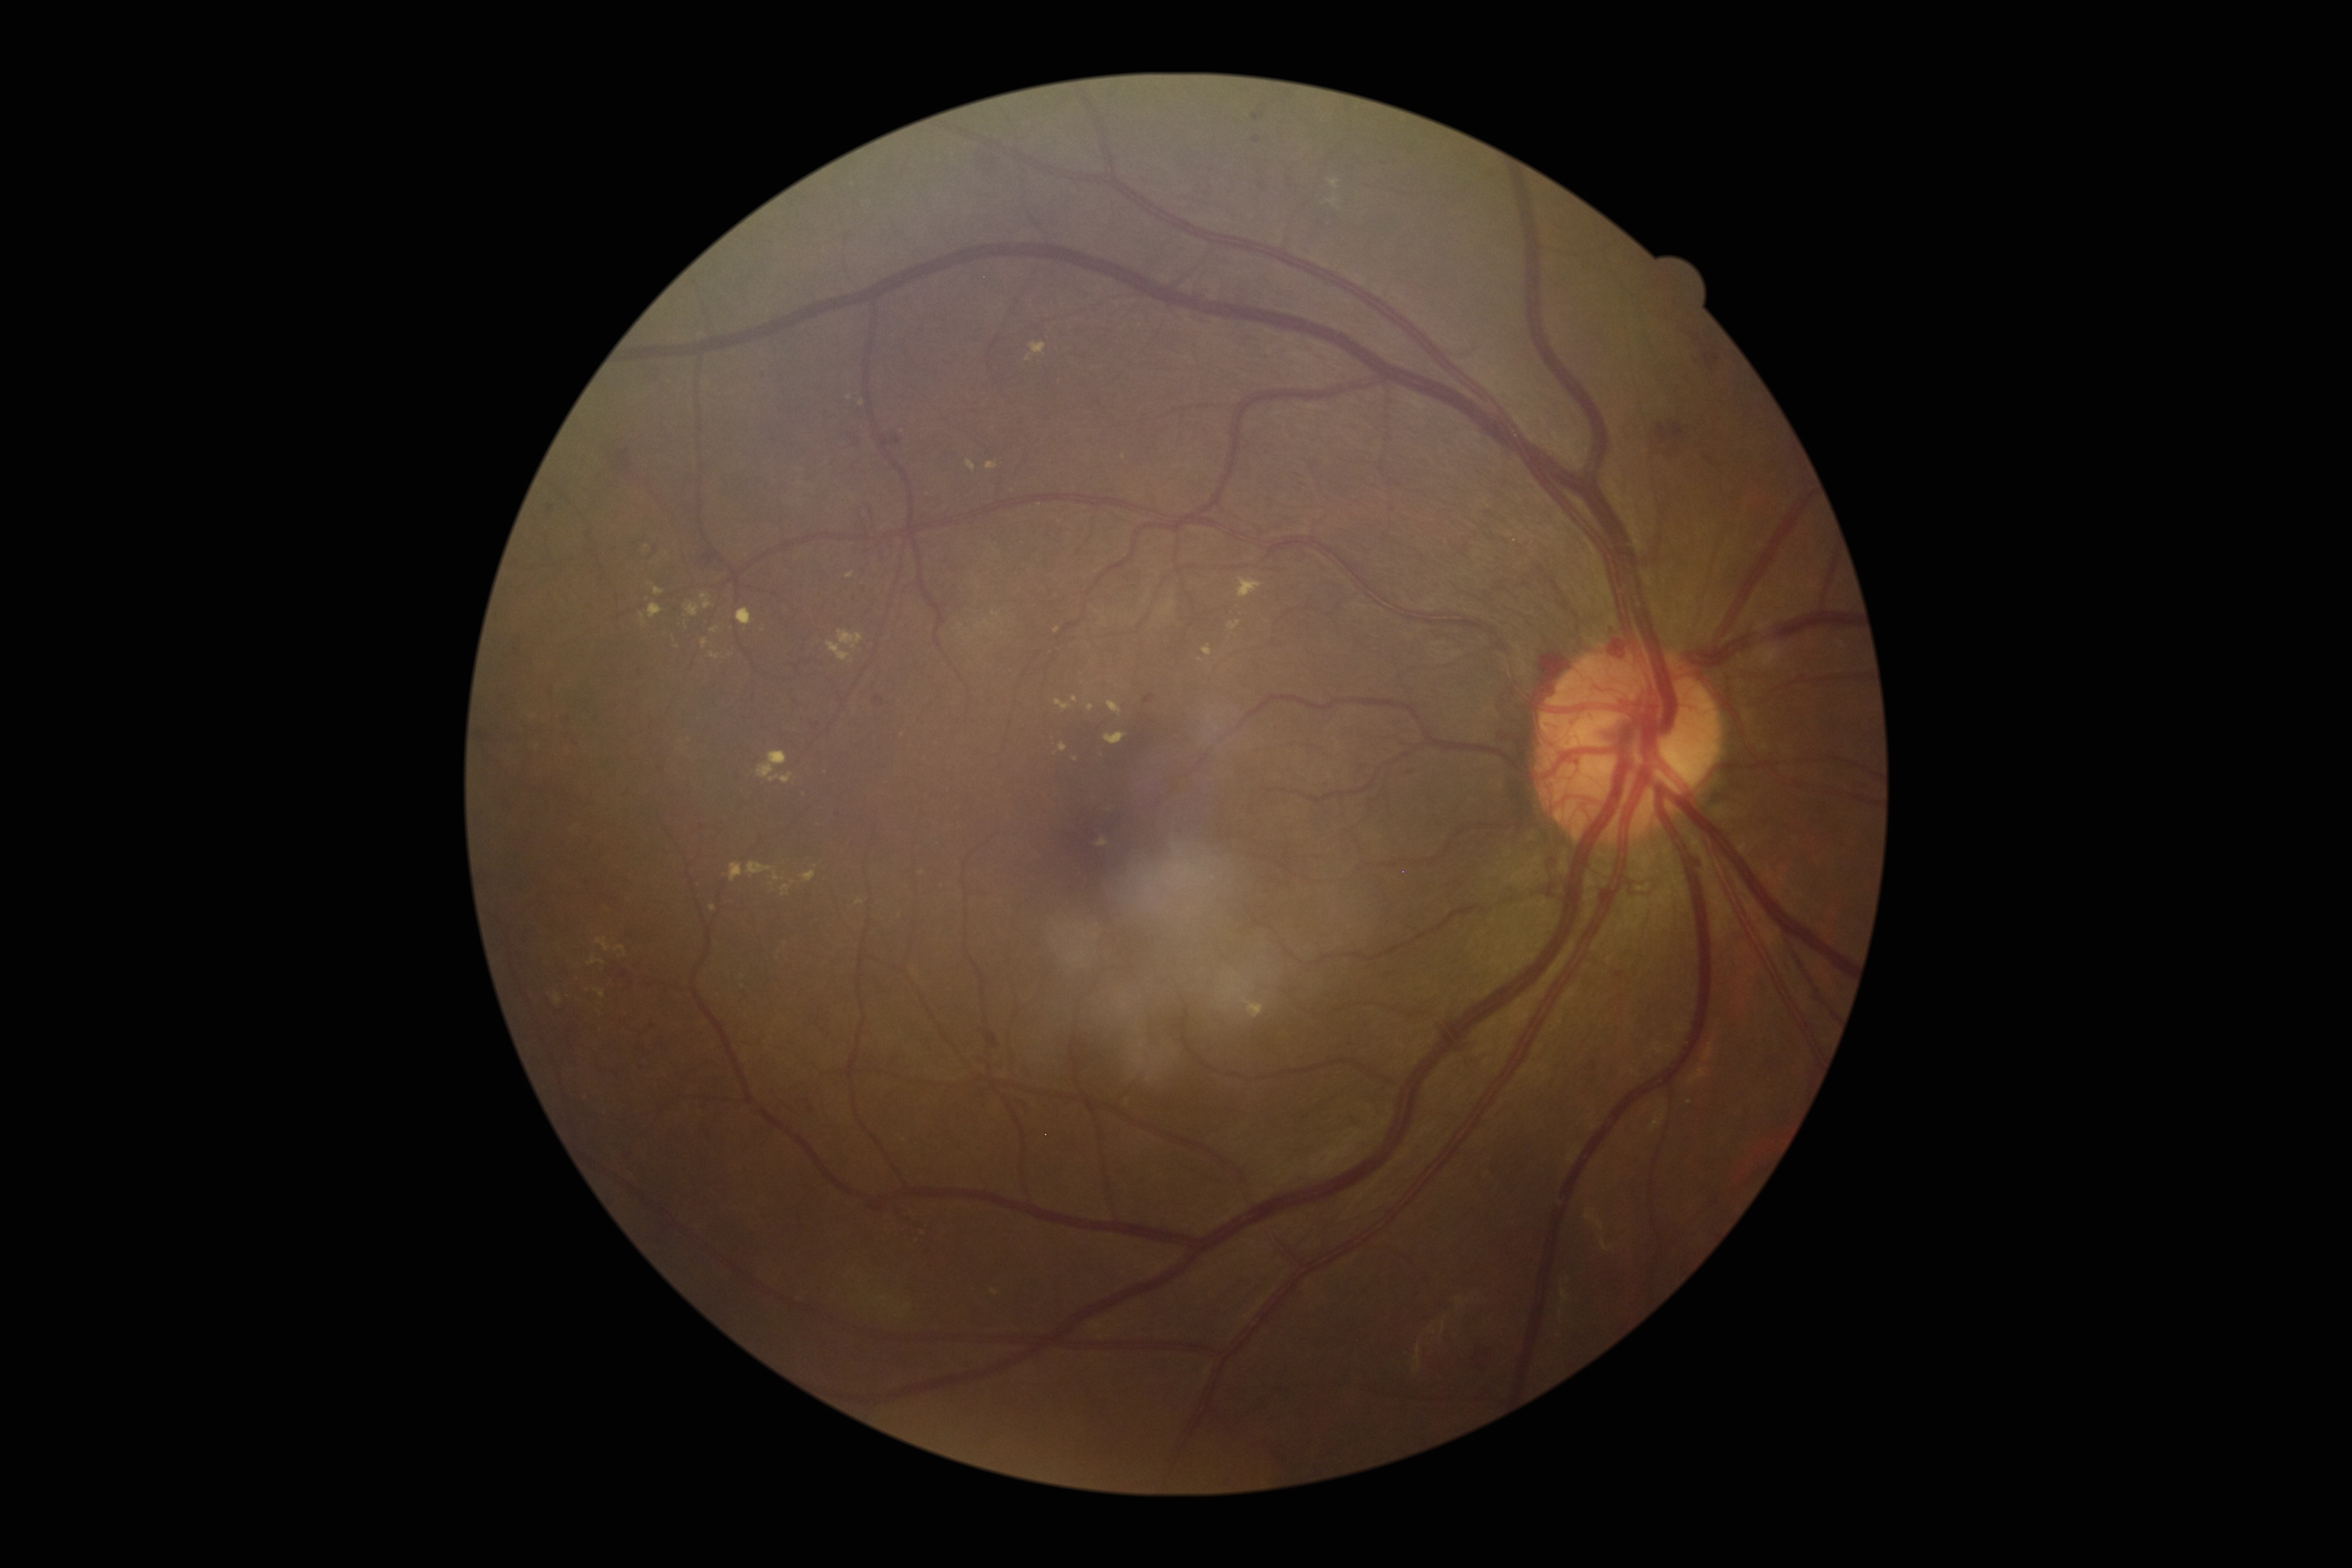 {"dr_grade": "proliferative diabetic retinopathy (grade 4)"}